Acquired on the Clarity RetCam 3 · pediatric wide-field fundus photograph: 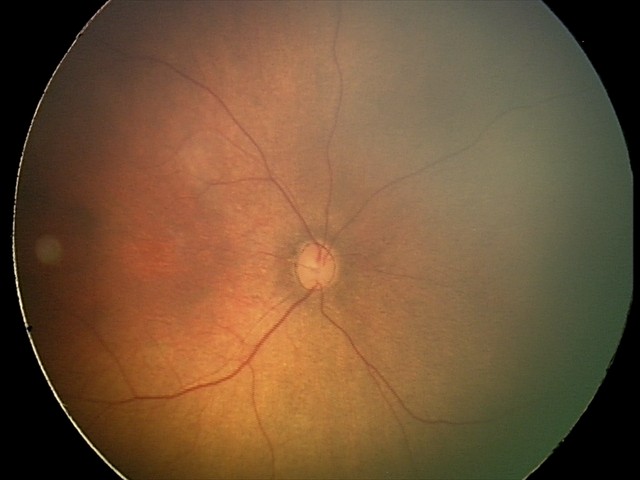
Normal screening examination.